No pharmacologic dilation. Graded on the modified Davis scale
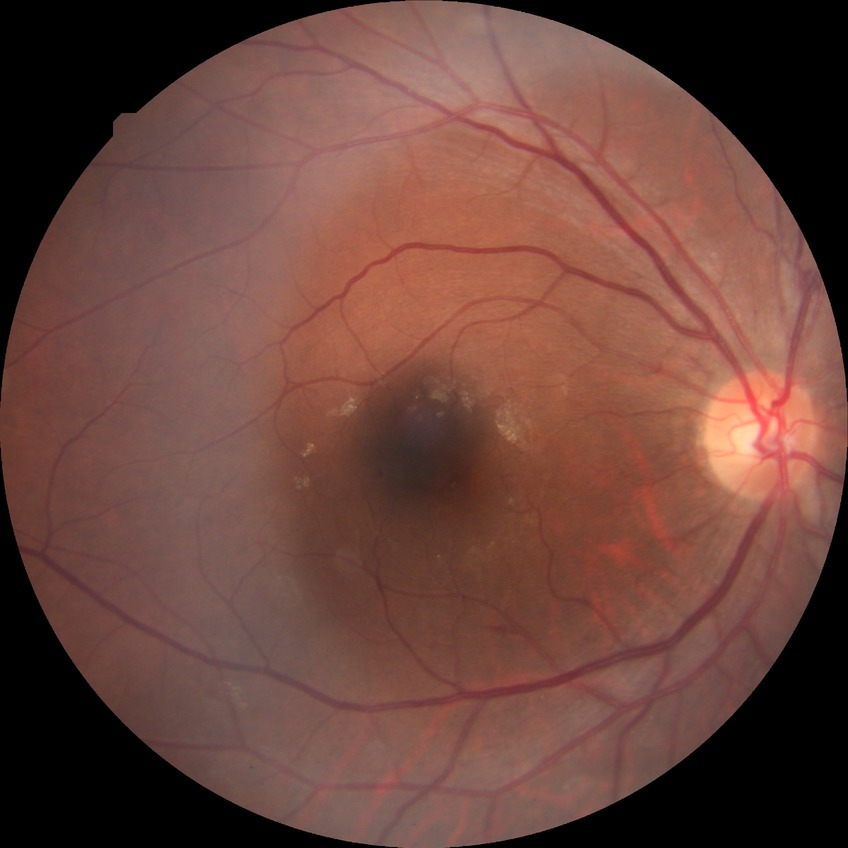

DR severity = SDR